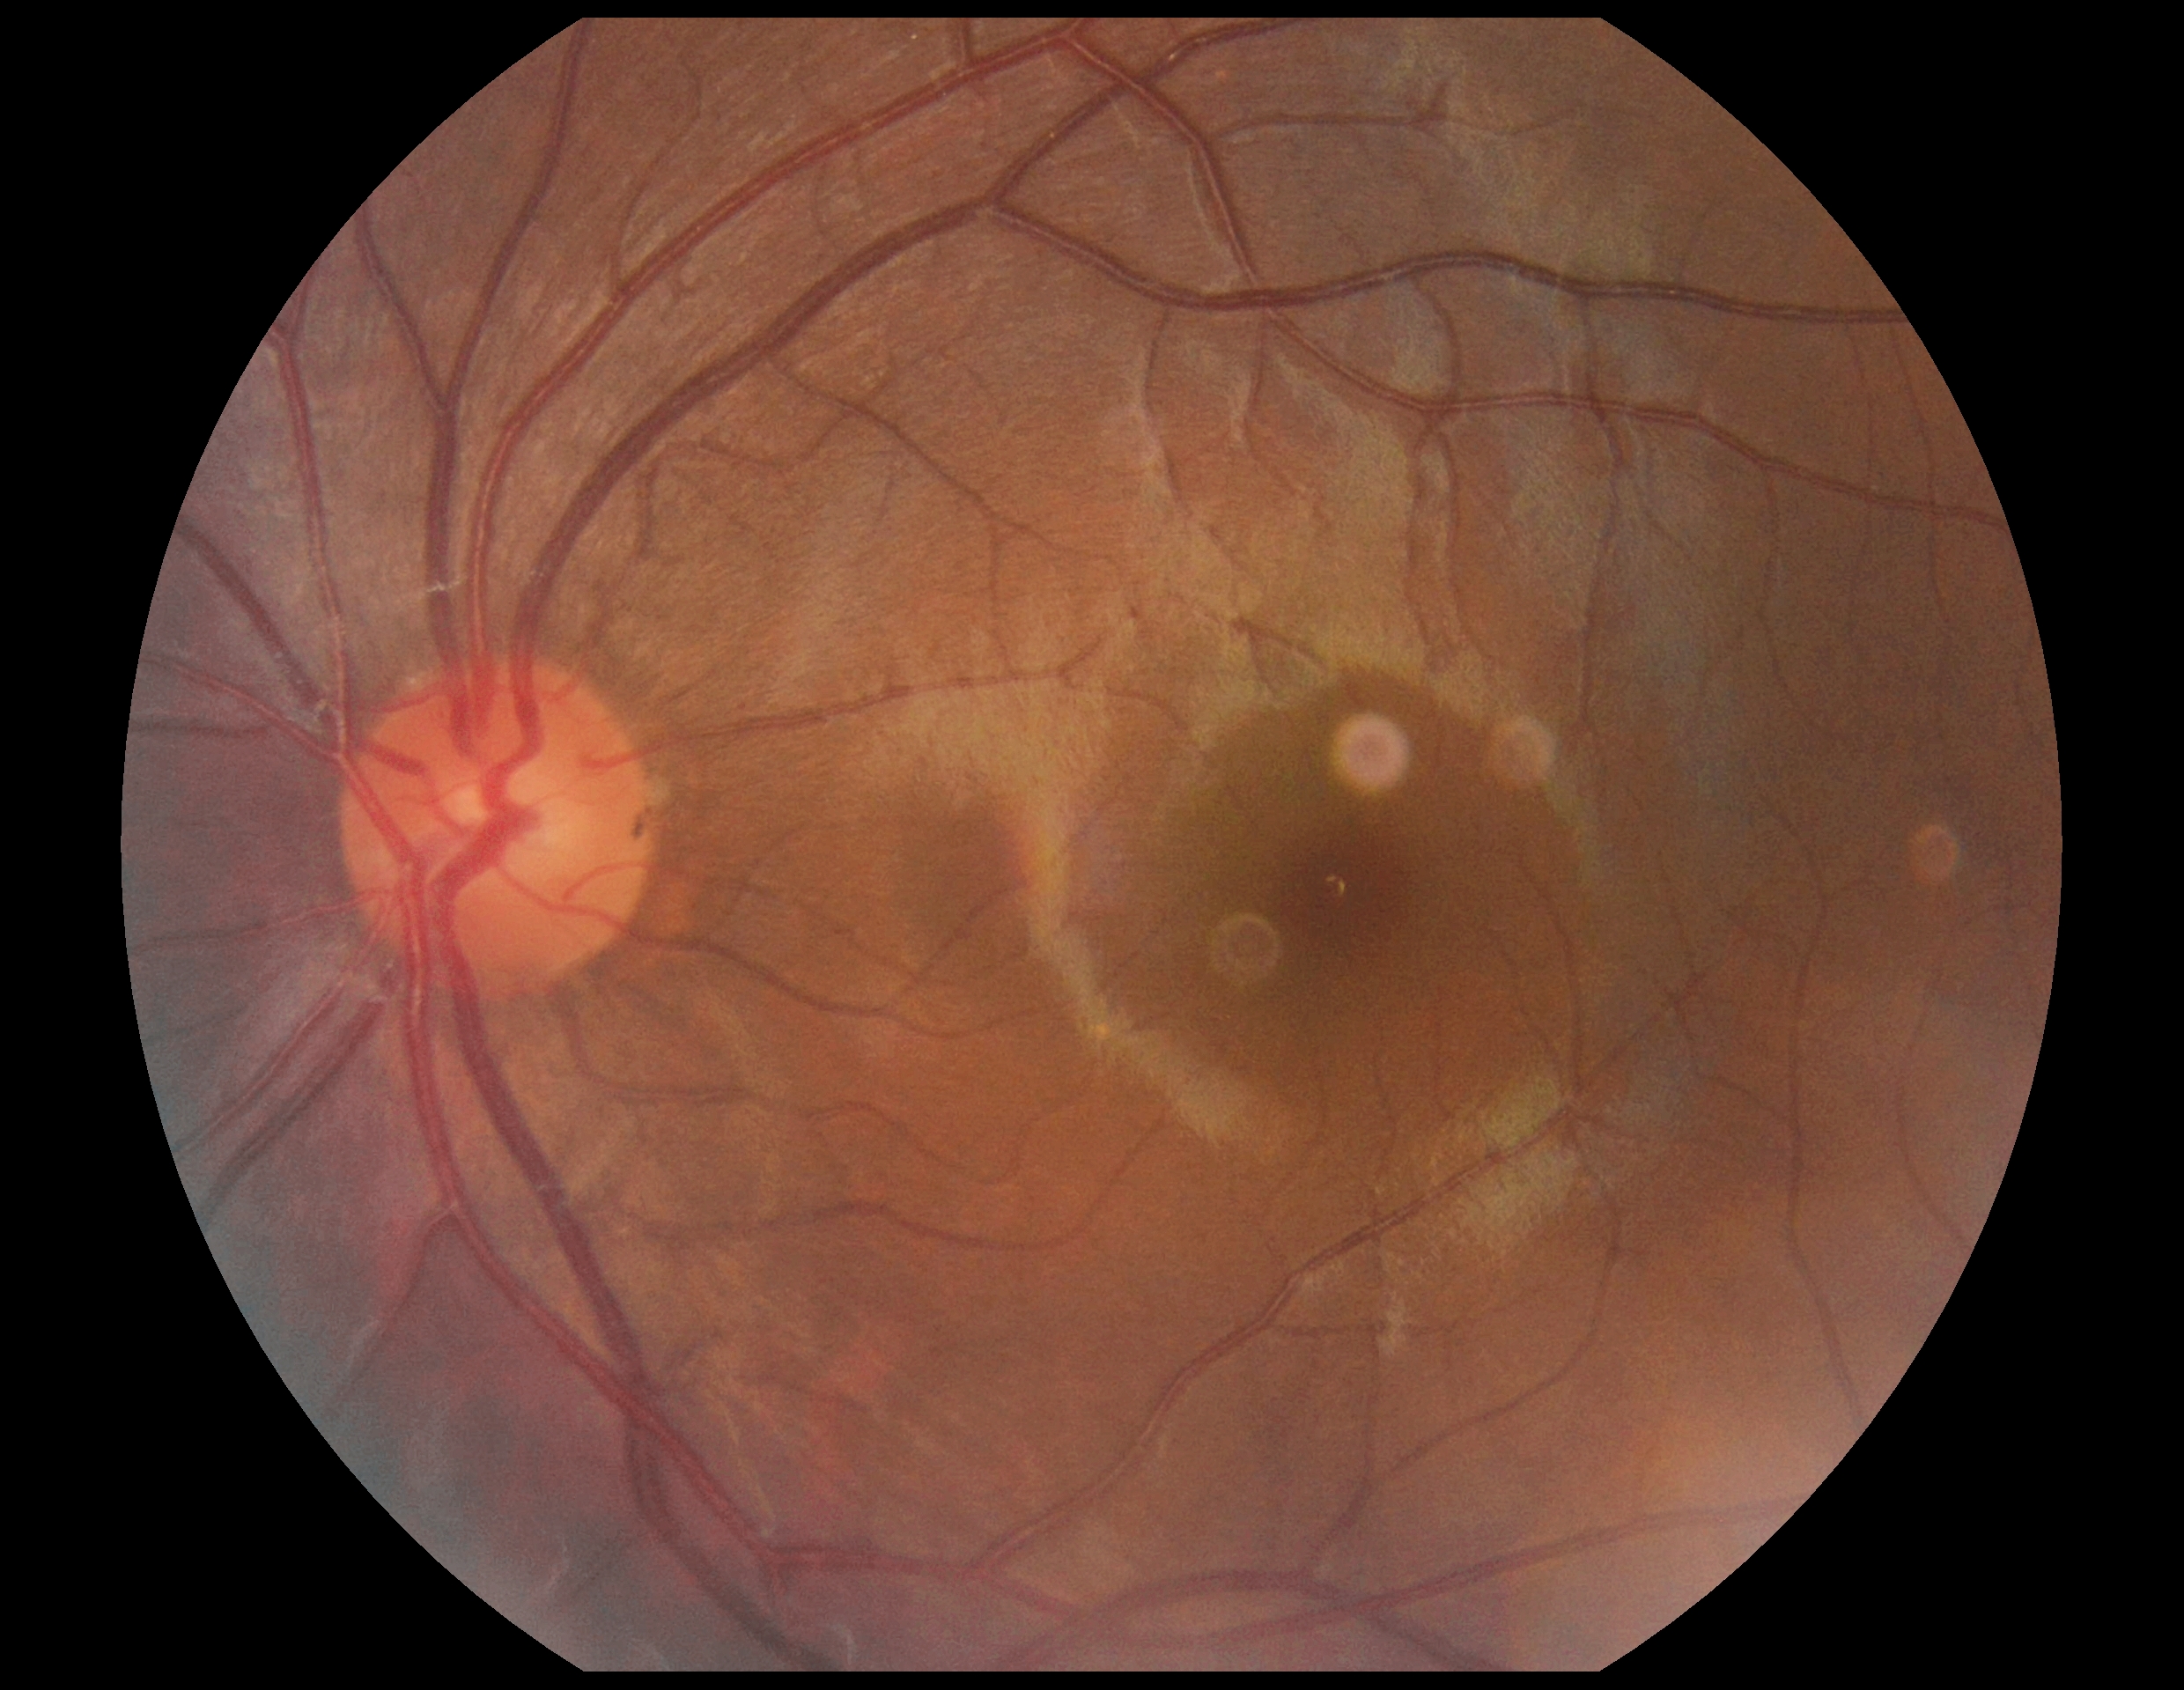
Annotations:
• DR severity — grade 0
• DR impression — negative for DR